1440x1080px. Acquired on the Natus RetCam Envision. Pediatric wide-field fundus photograph
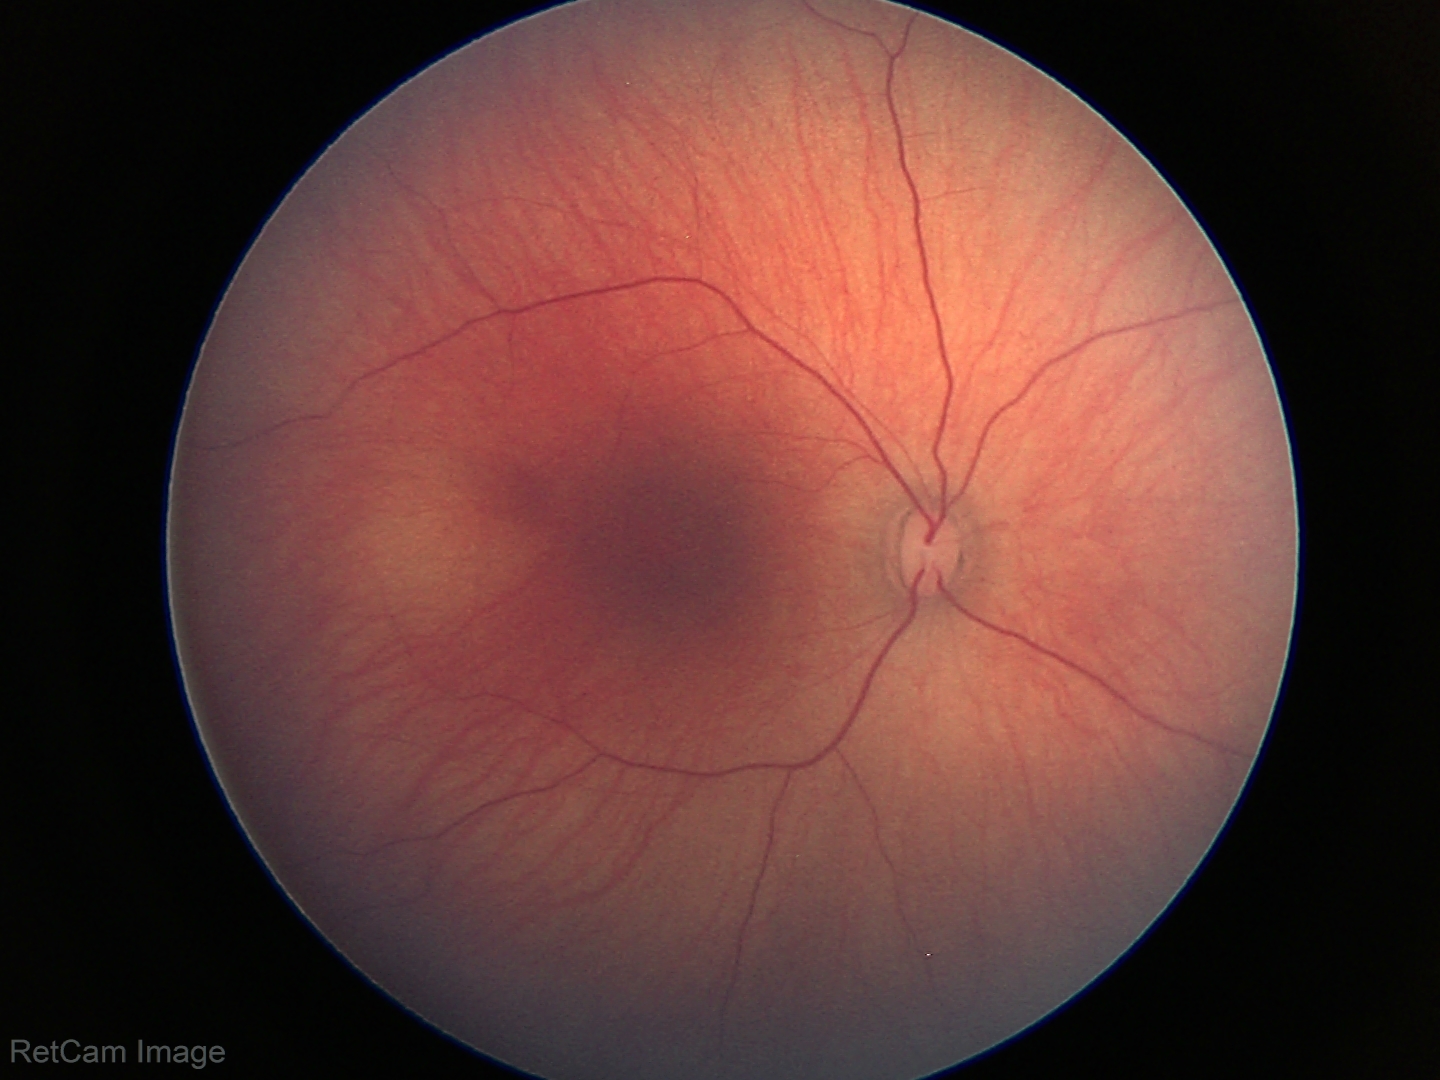 Finding = no pathology identified